CFP · 45-degree field of view:
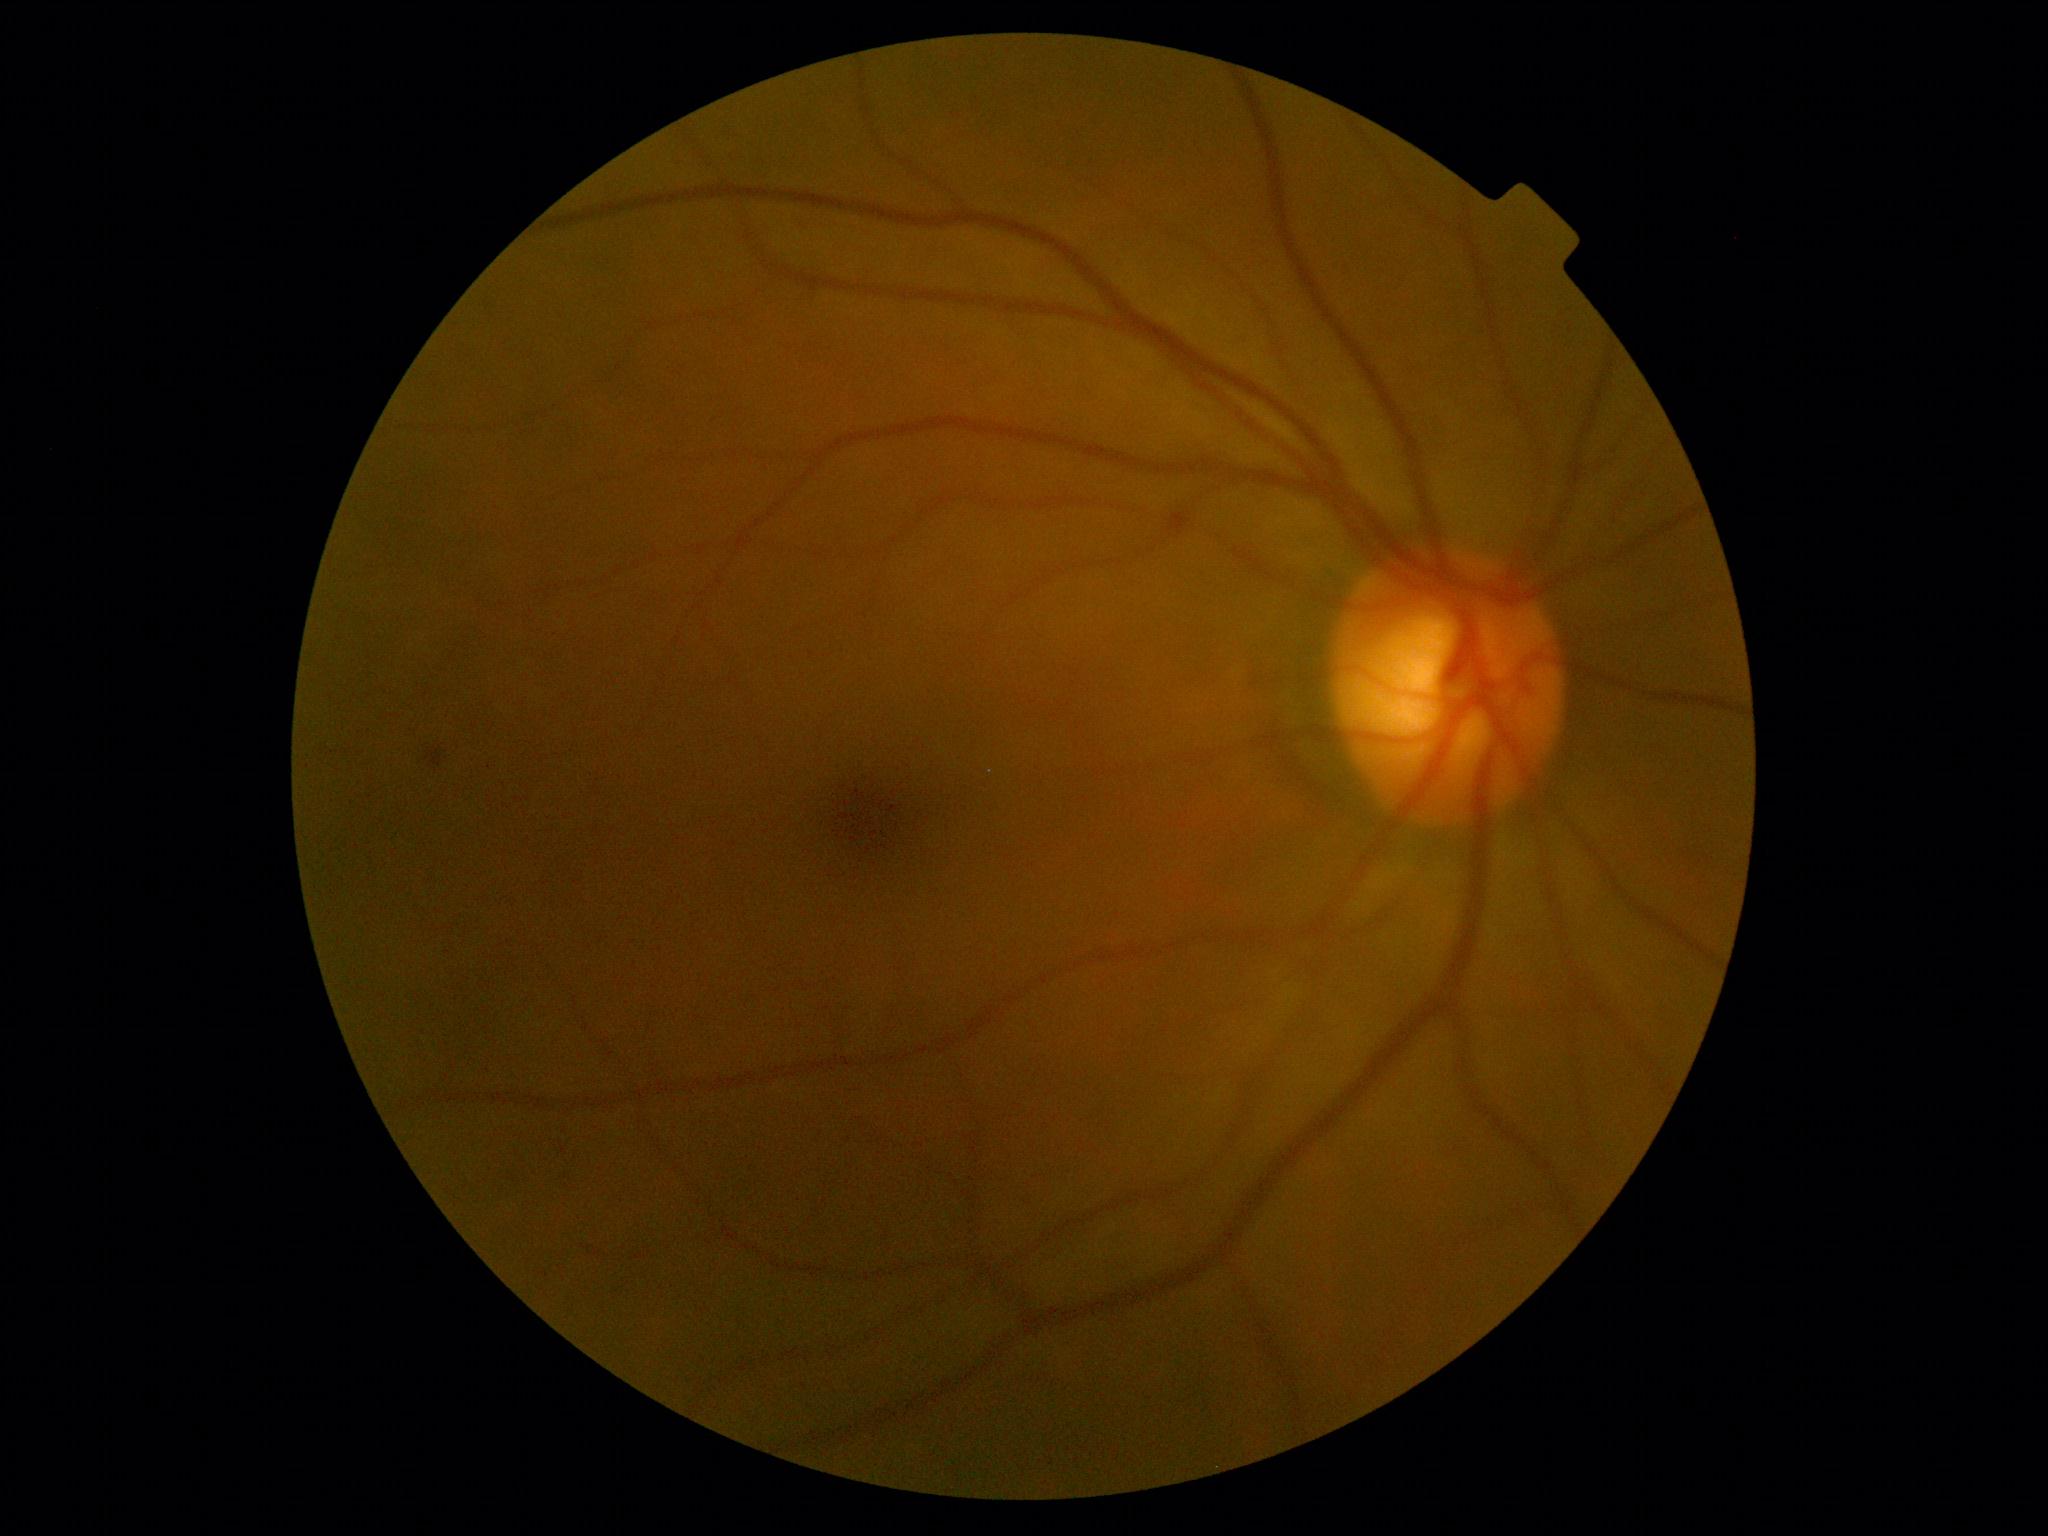
No diabetic retinal disease findings.
Retinopathy: grade 0 (no apparent retinopathy).